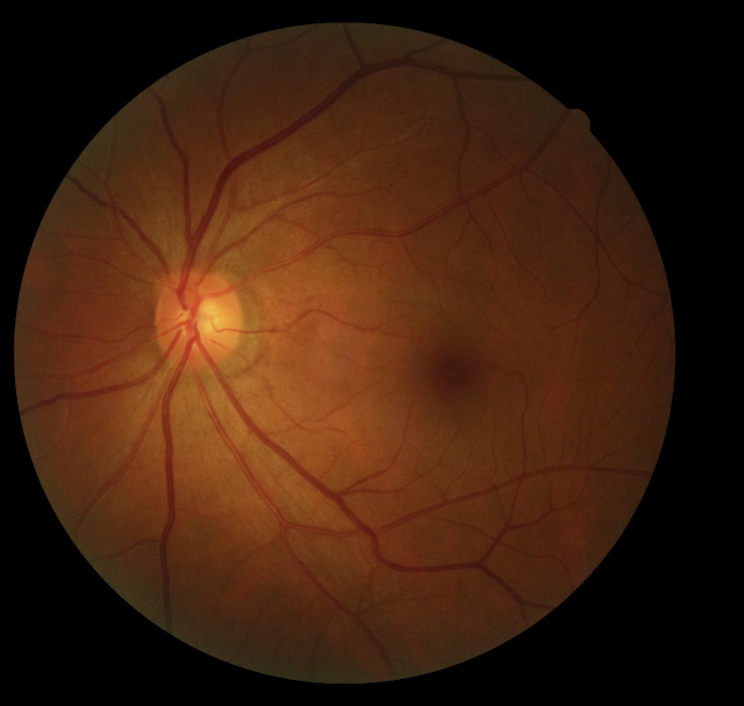
diabetic retinopathy severity@grade 0 — no visible signs of diabetic retinopathy.